Pupil-dilated.
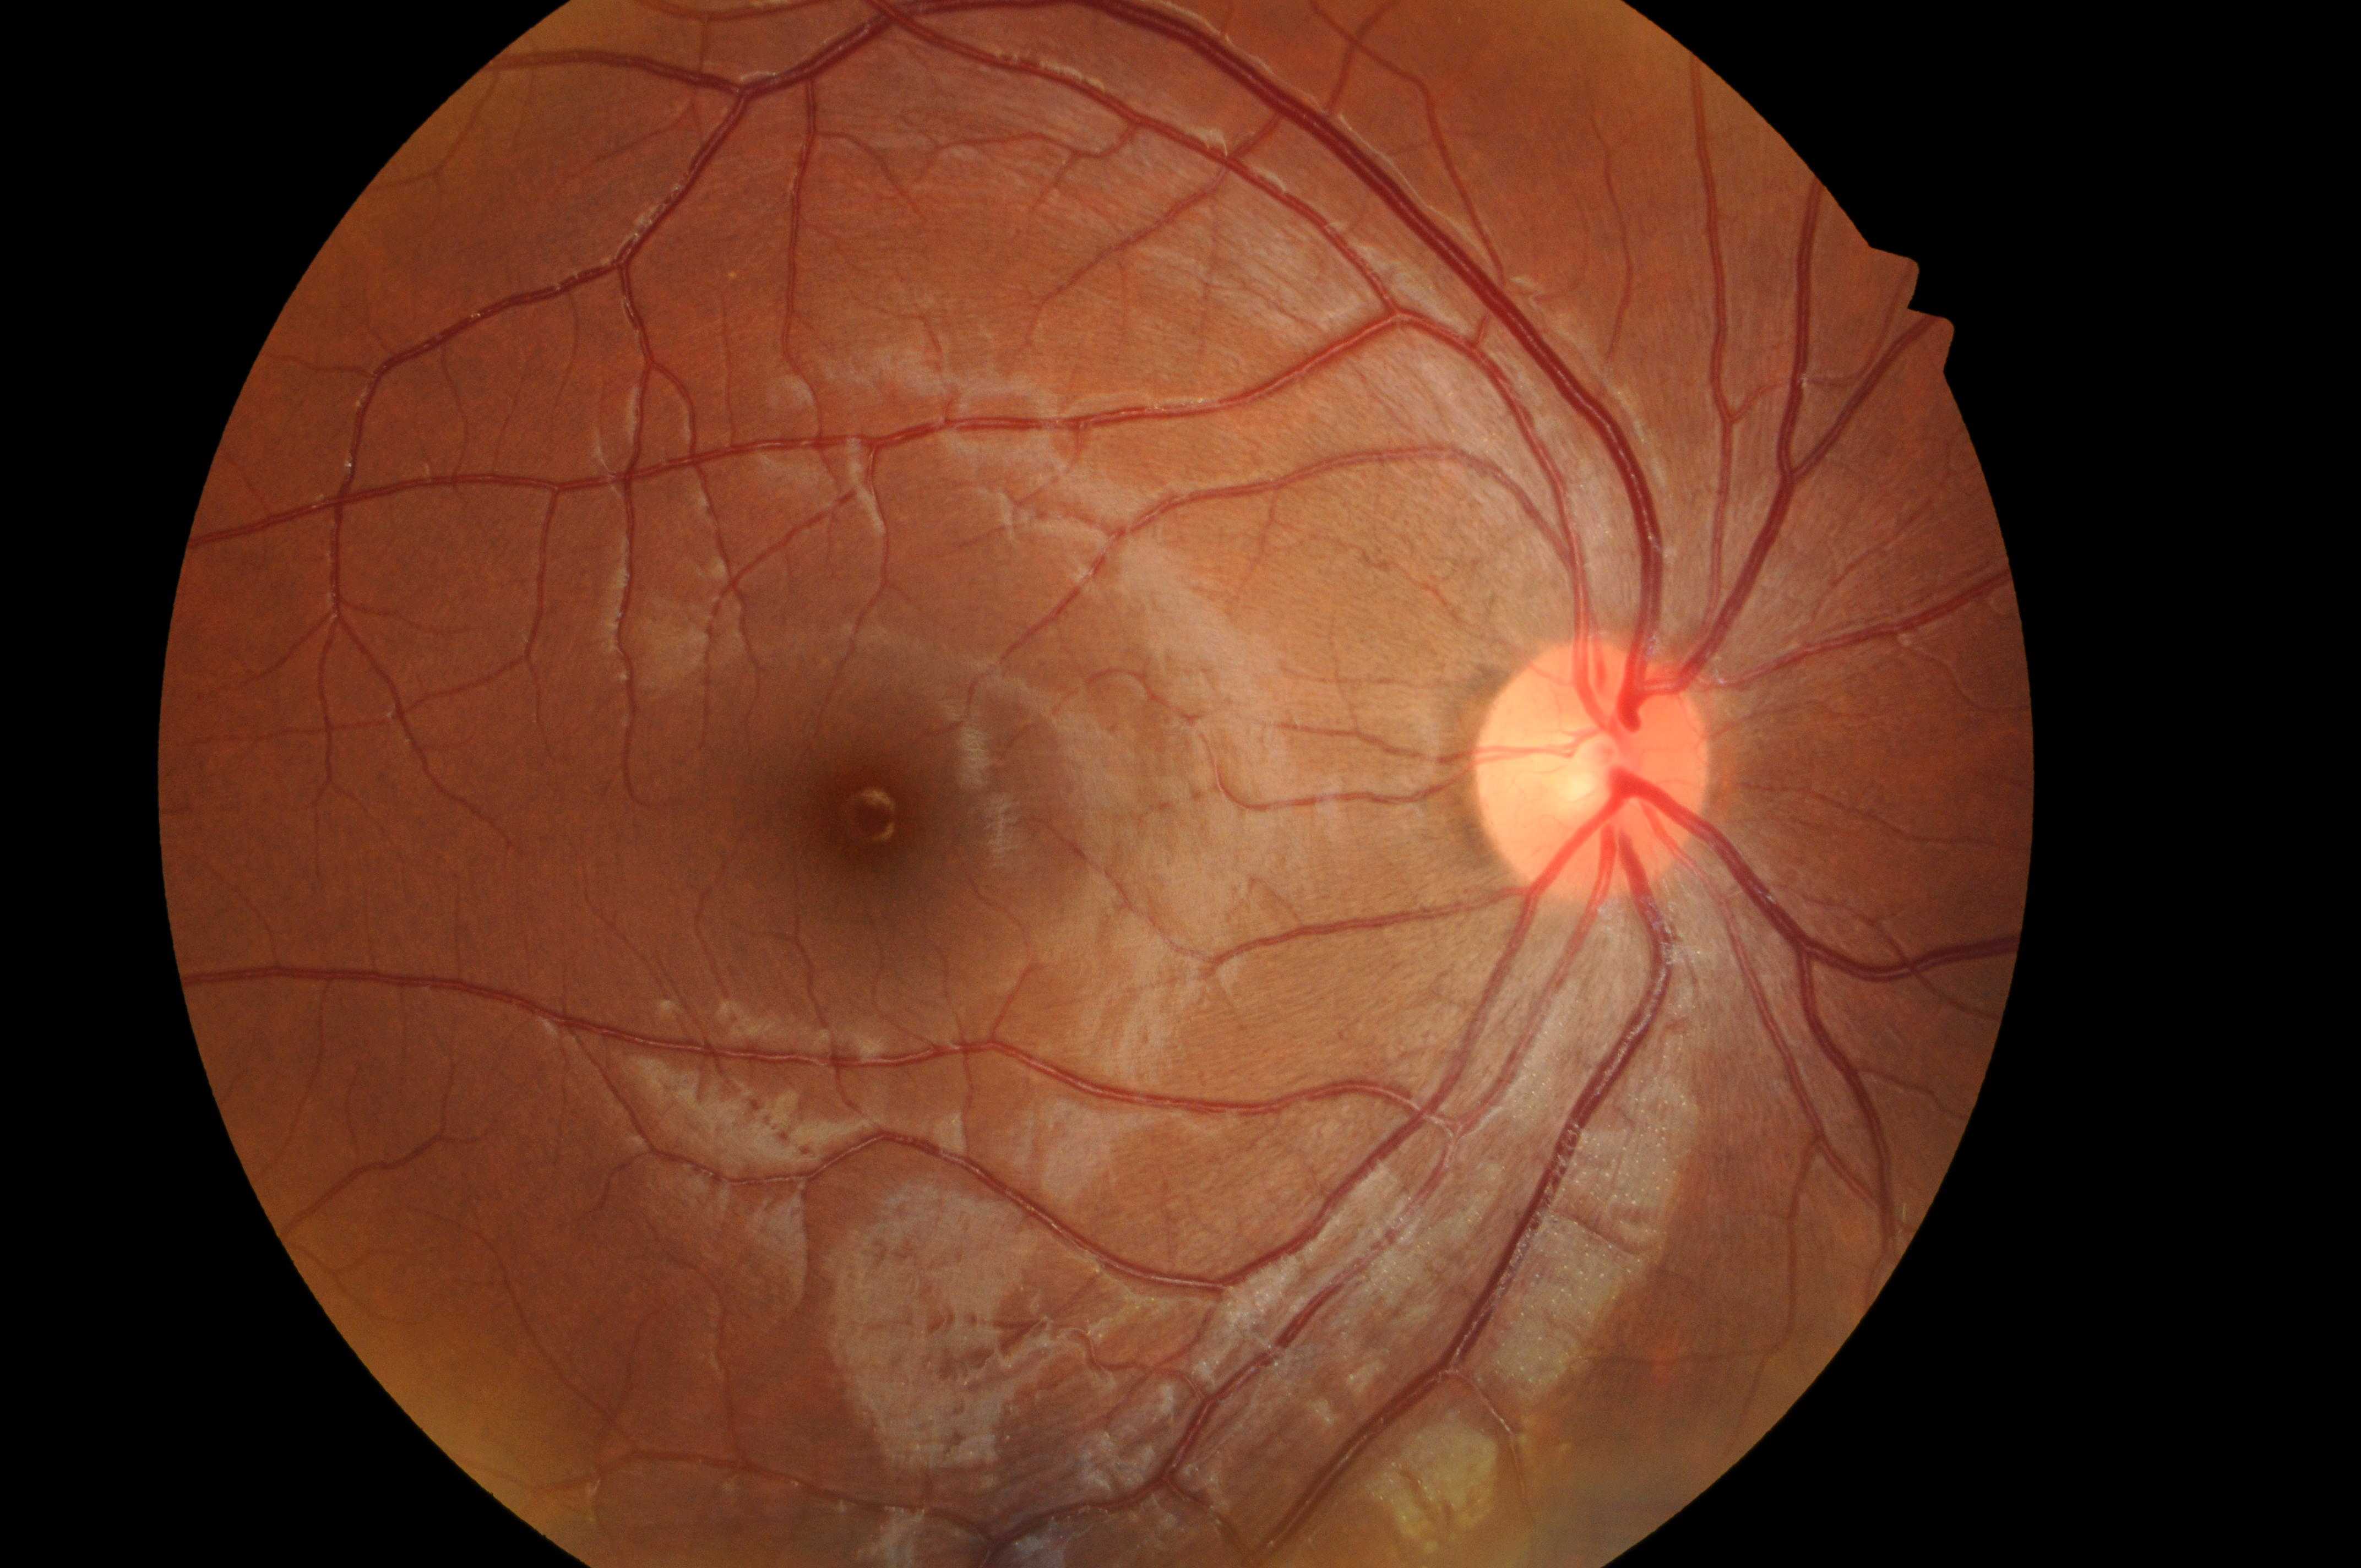
laterality: the right eye
optic disc center: [1592, 779]
DR impression: No DR or DME findings
macula center: [879, 818]
DR stage: grade 0
DME grade: 0